45° FOV:
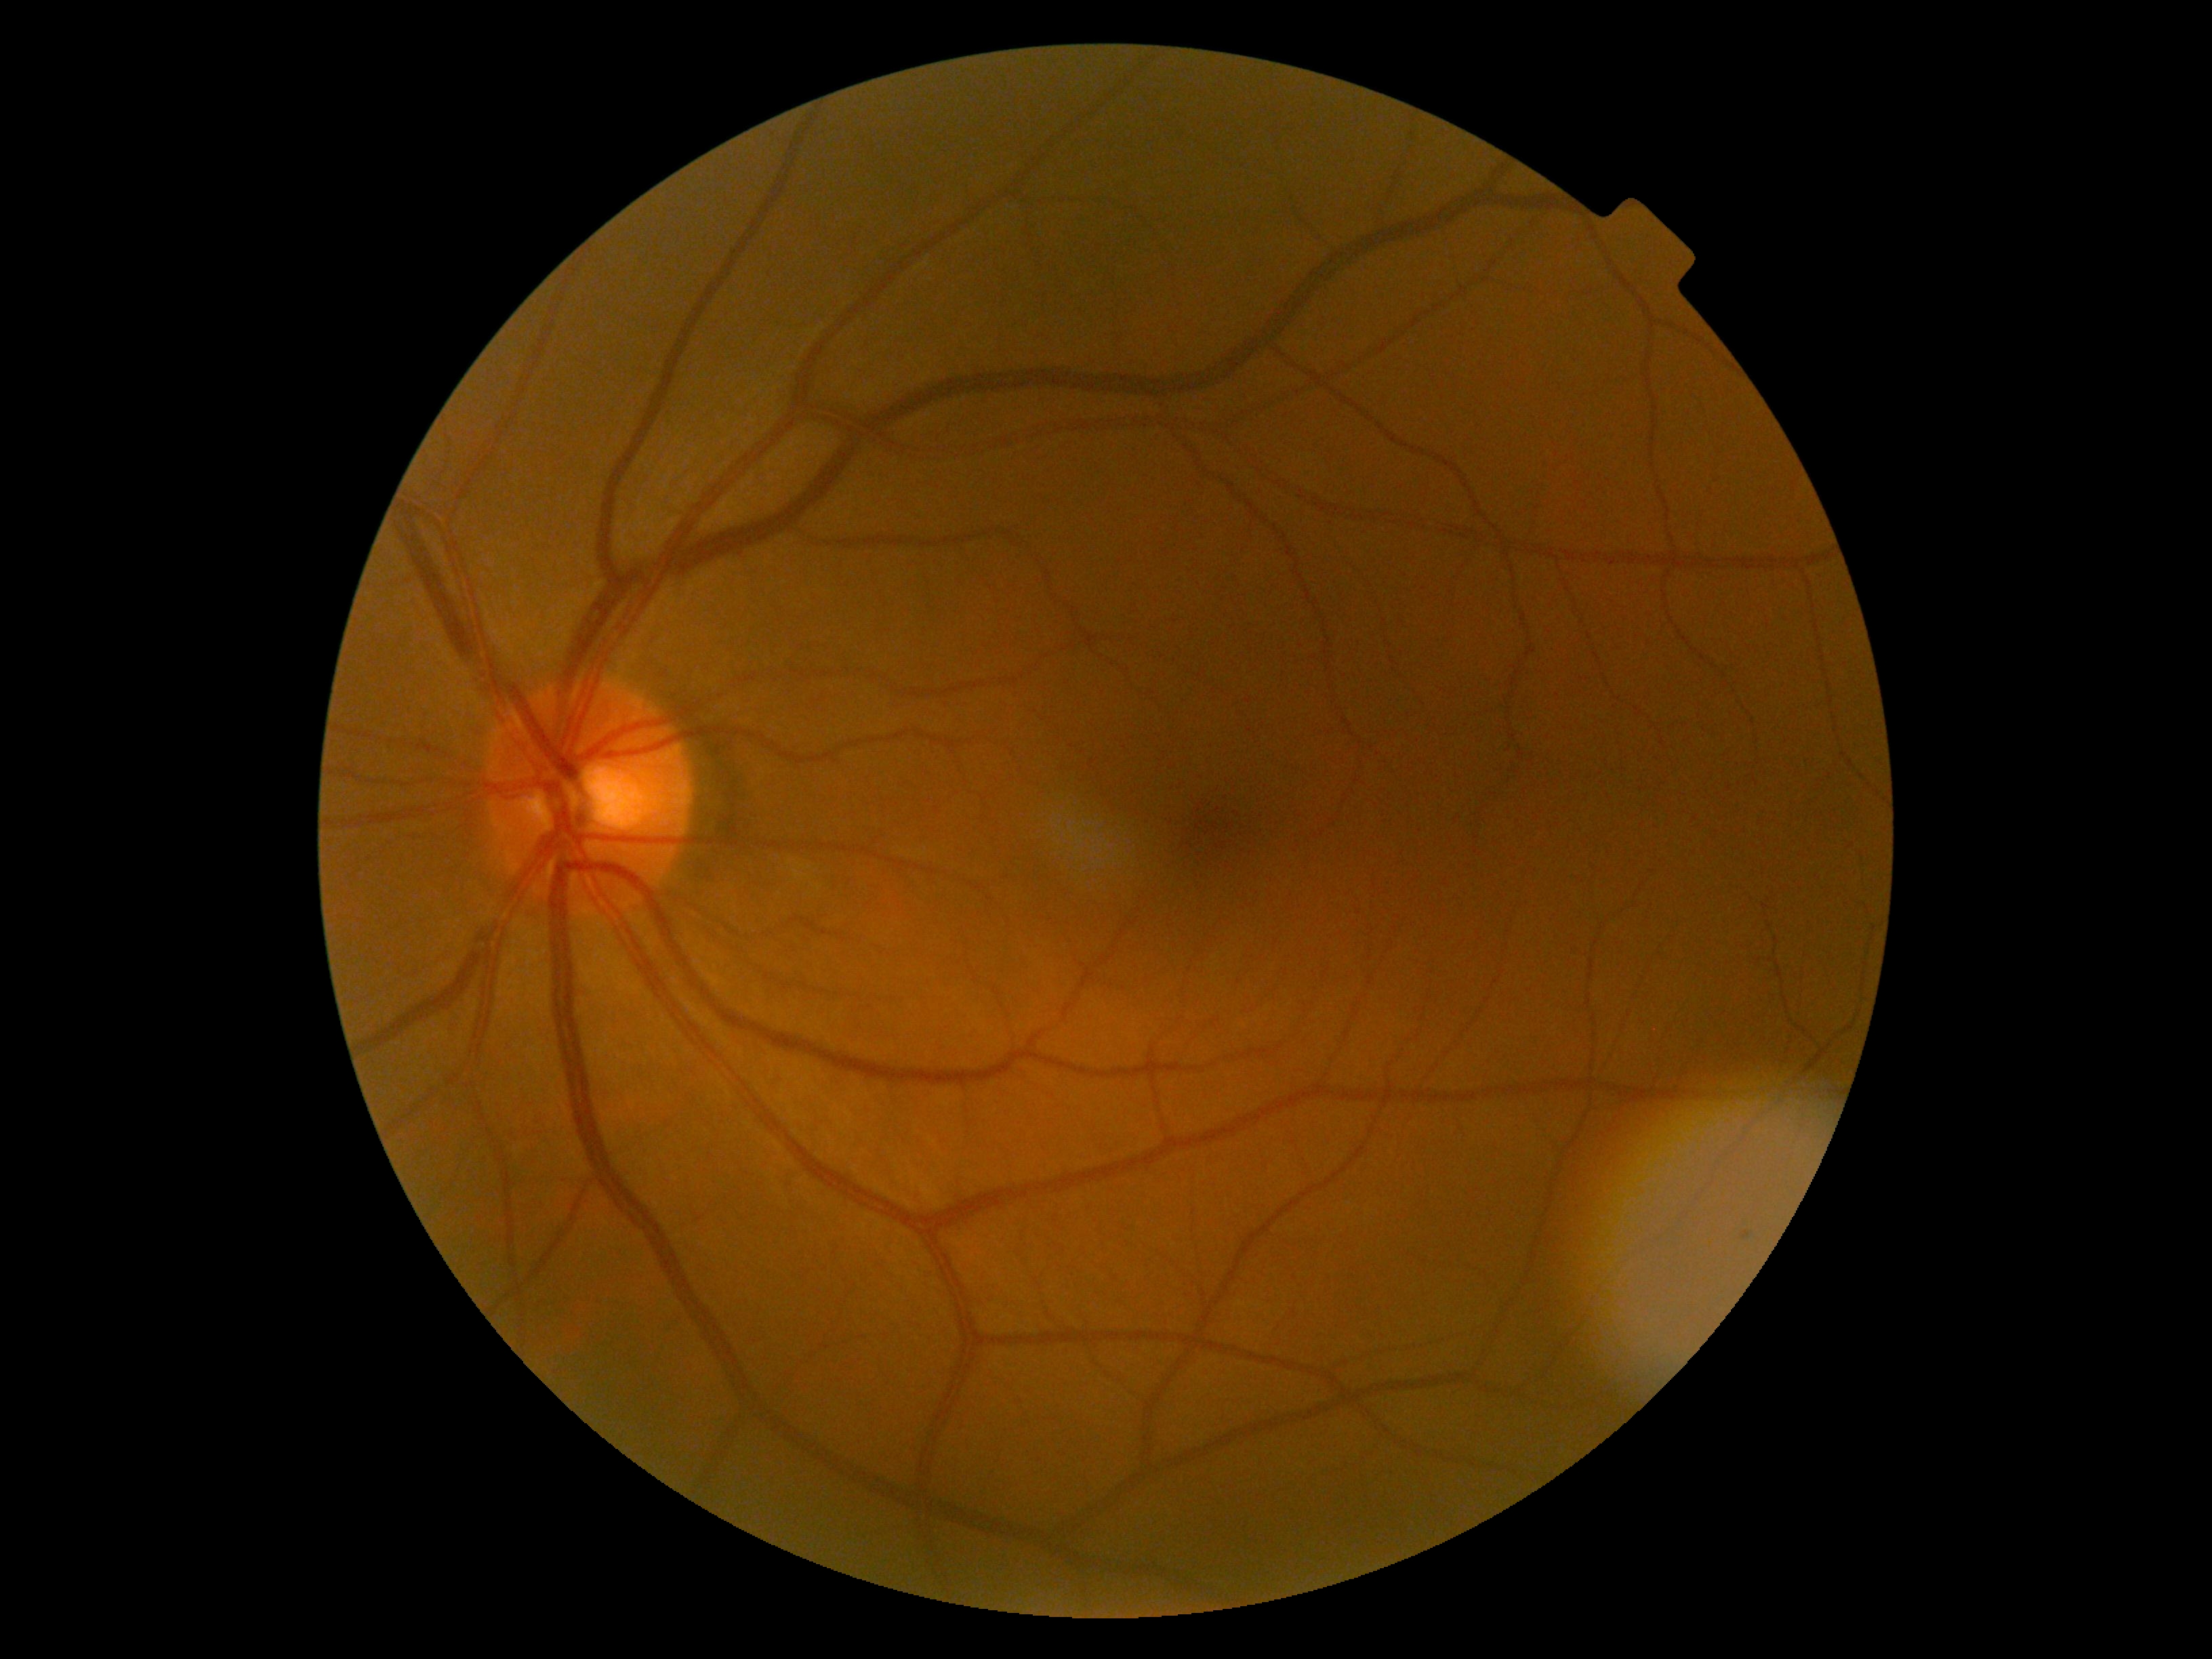
Diabetic retinopathy (DR): 0. No DR findings.